Acquired on the Natus RetCam Envision; wide-field fundus image from infant ROP screening.
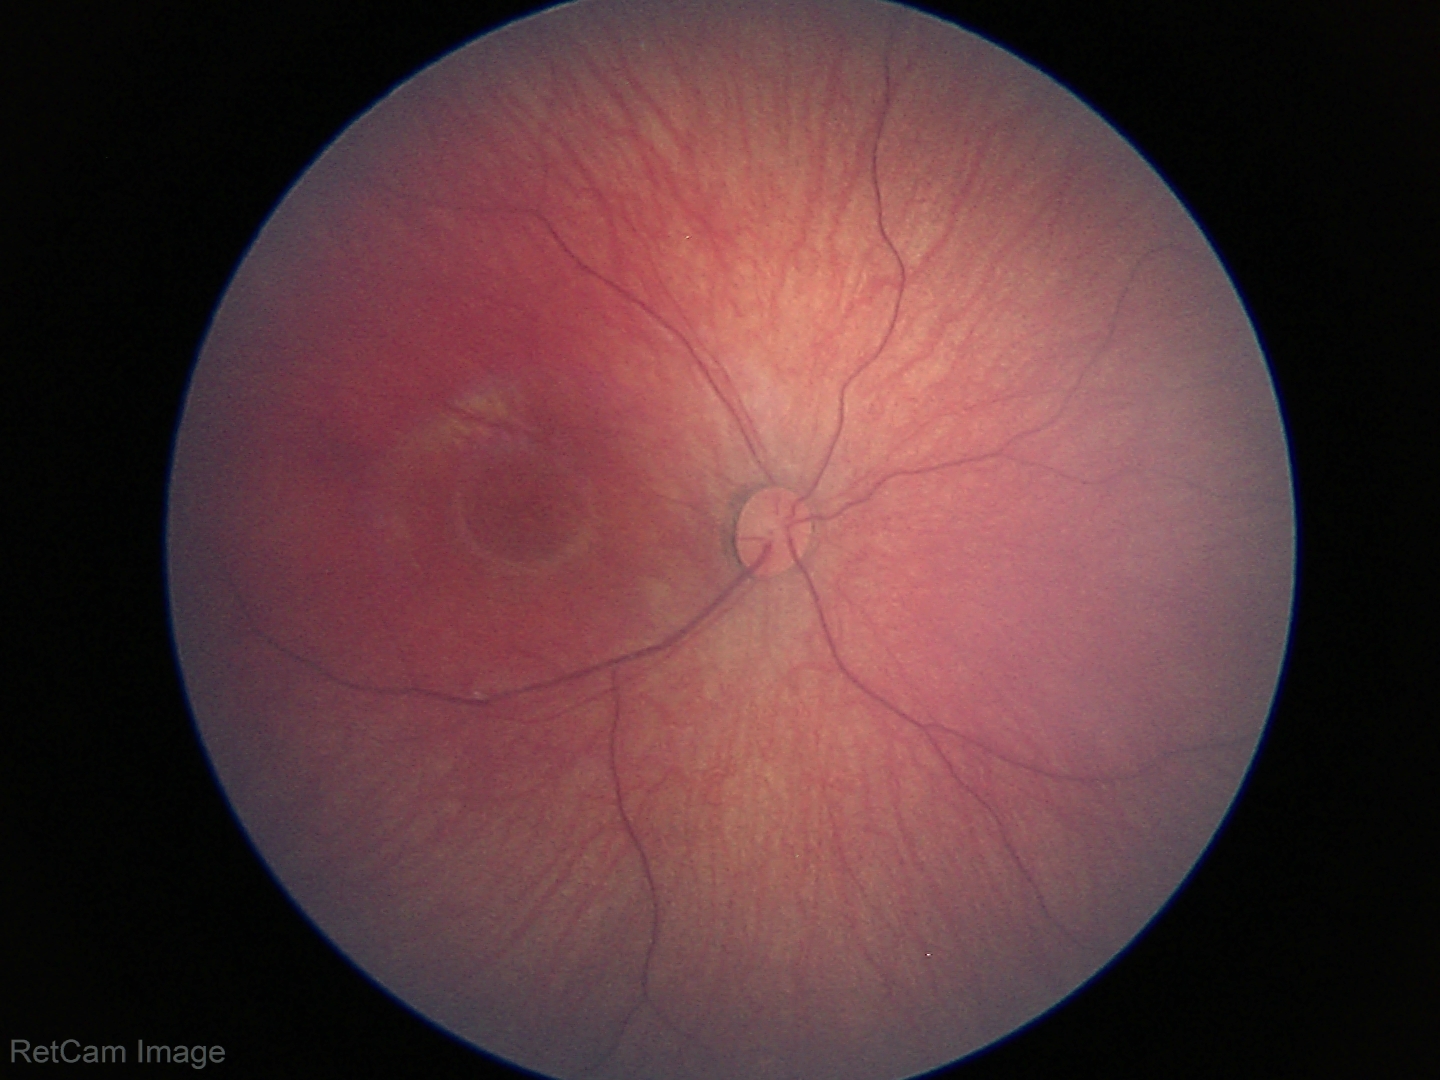 Assessment: no abnormalities.